848 by 848 pixels; nonmydriatic fundus photograph; NIDEK AFC-230; 45 degree fundus photograph; diabetic retinopathy graded by the modified Davis classification — 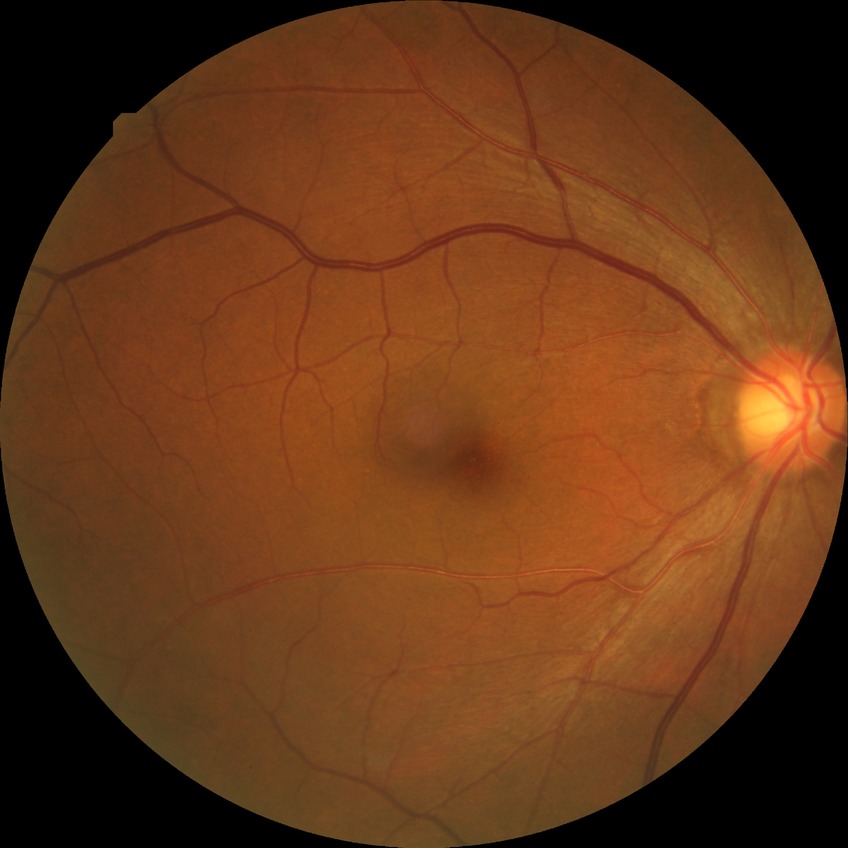 Diabetic retinopathy grade is no diabetic retinopathy.